2352x1568px — 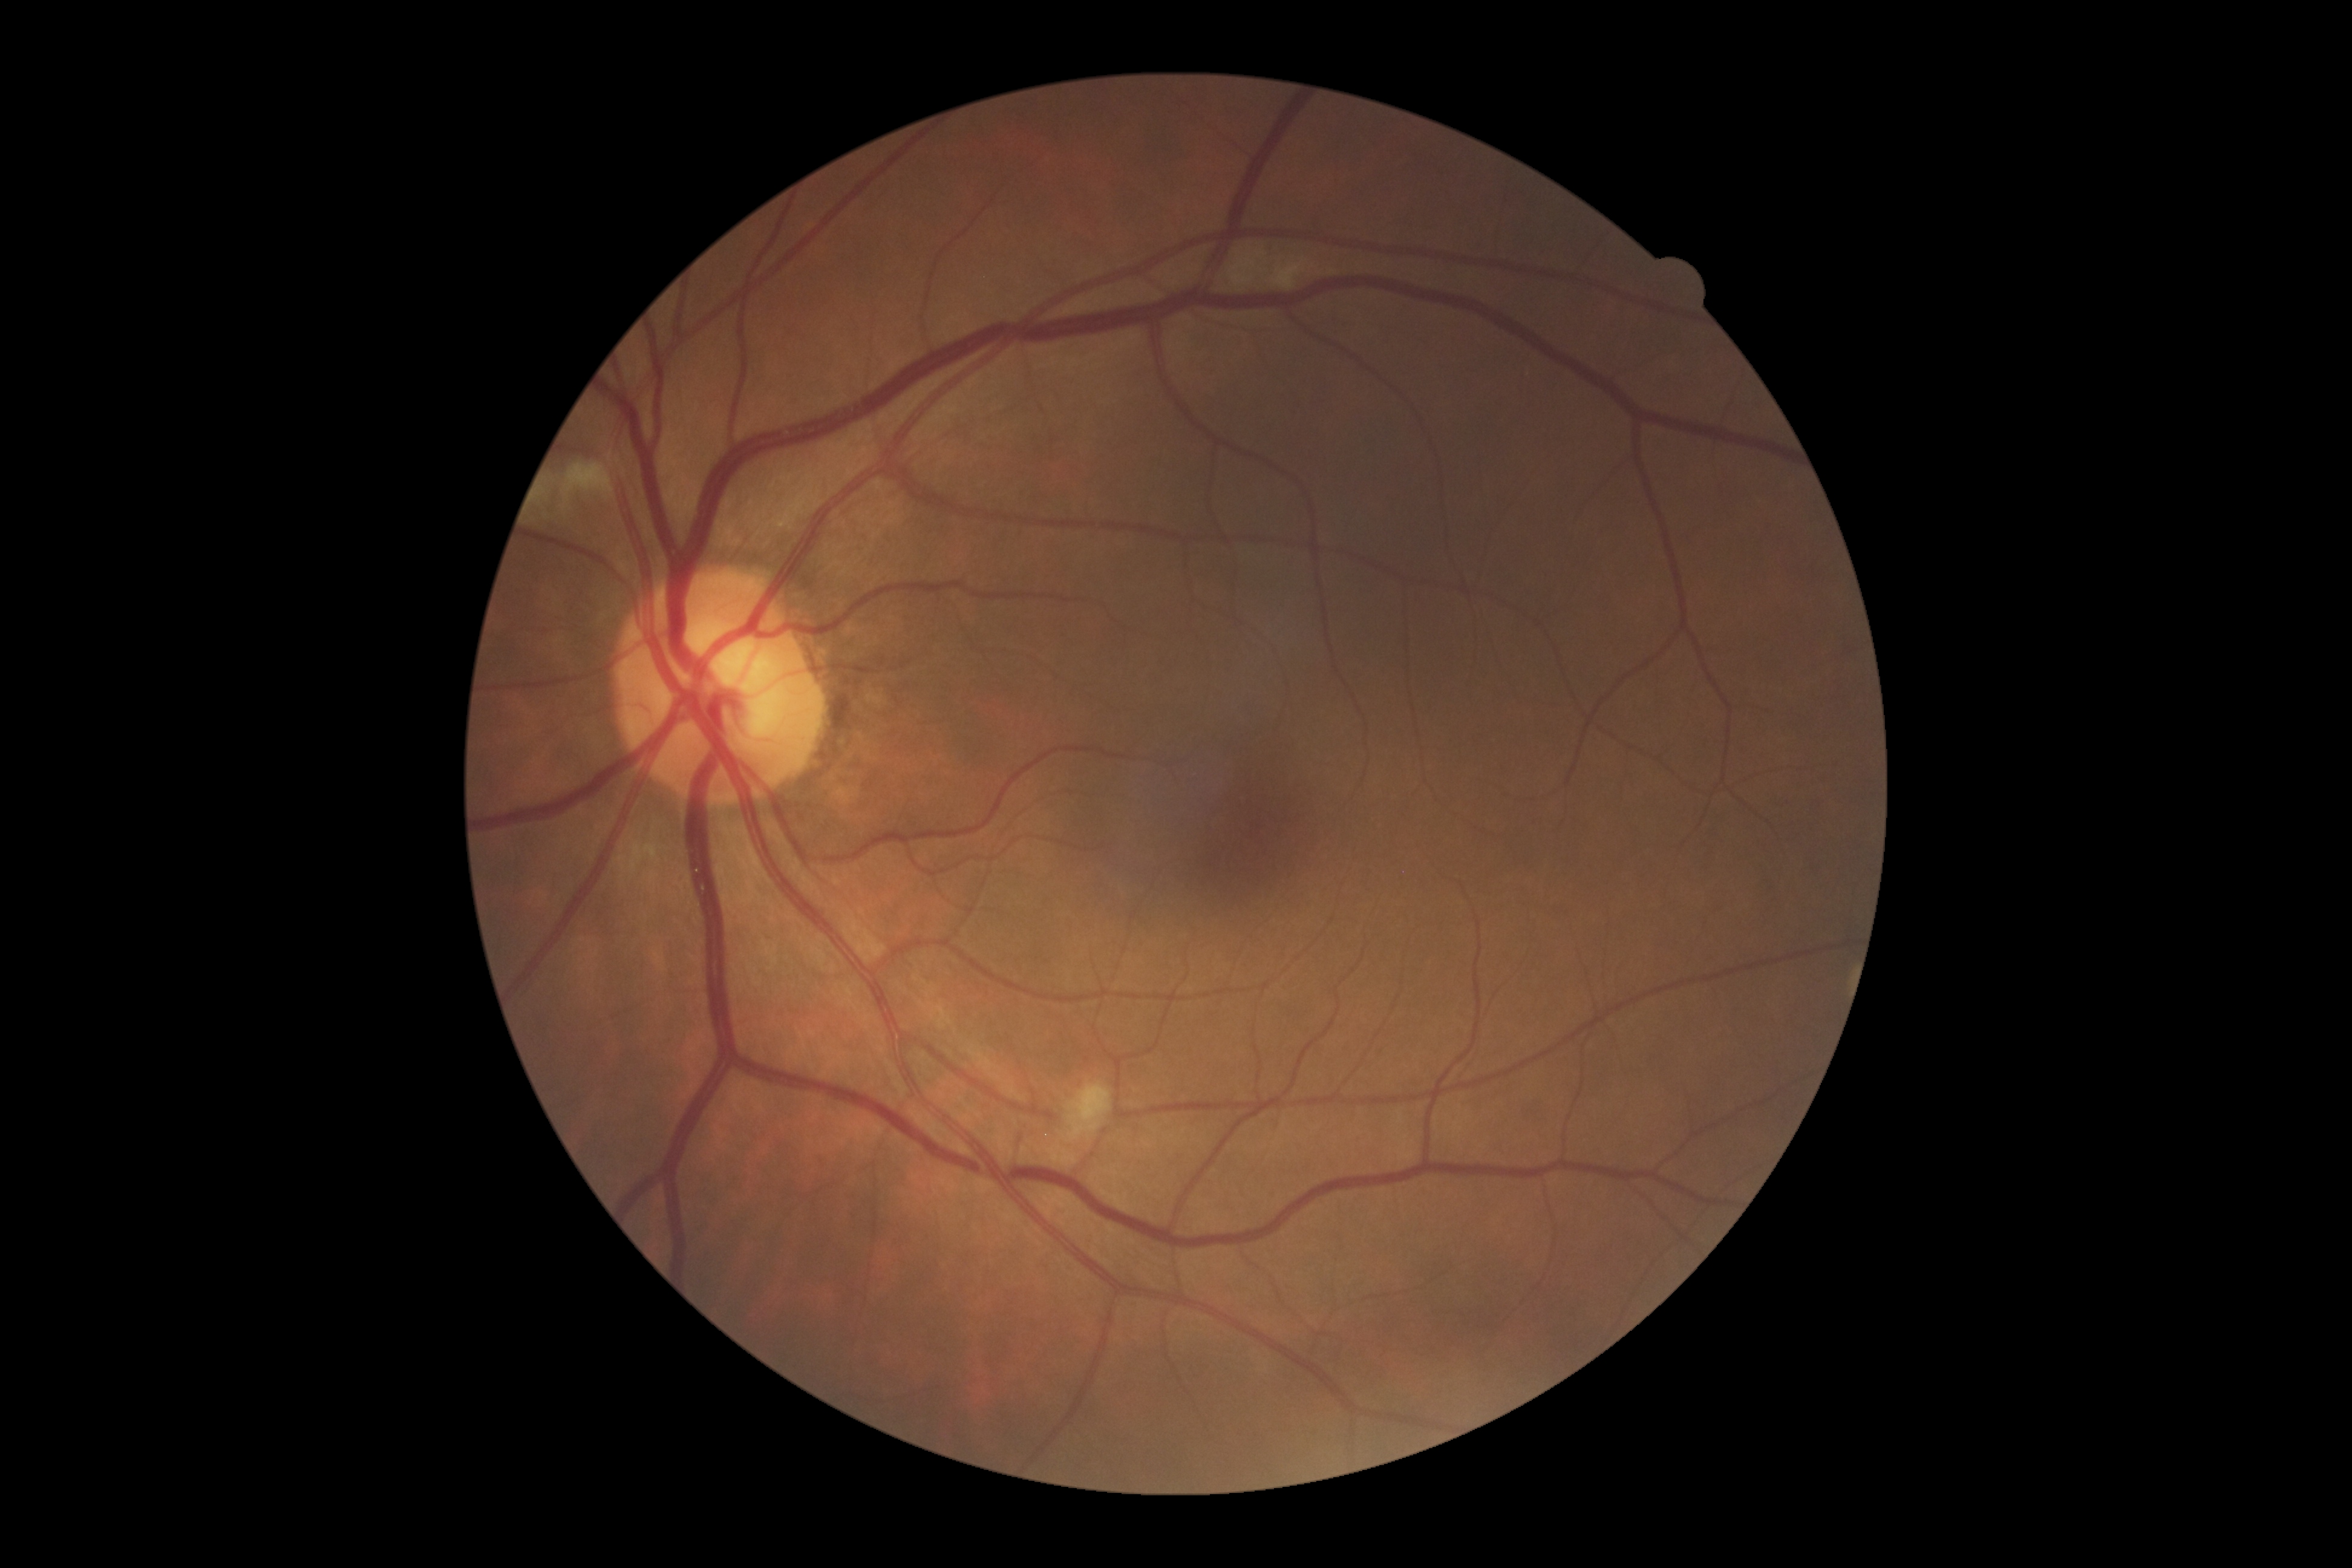

Diabetic retinopathy (DR) is 2/4.